Nonmydriatic, NIDEK AFC-230, diabetic retinopathy graded by the modified Davis classification:
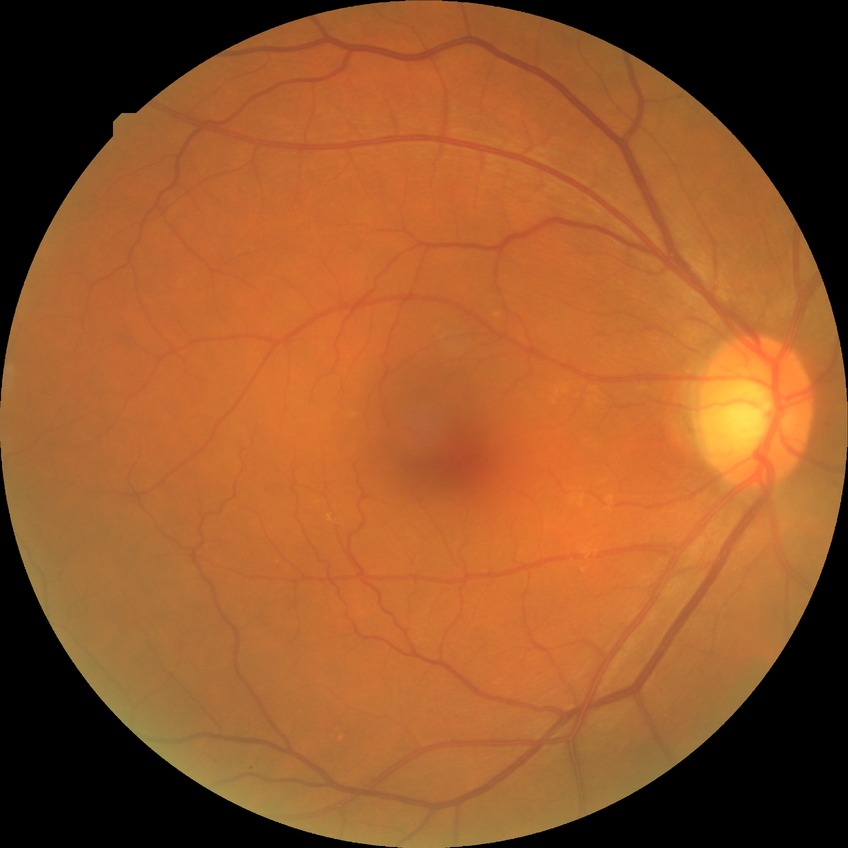

Modified Davis grading: simple diabetic retinopathy.